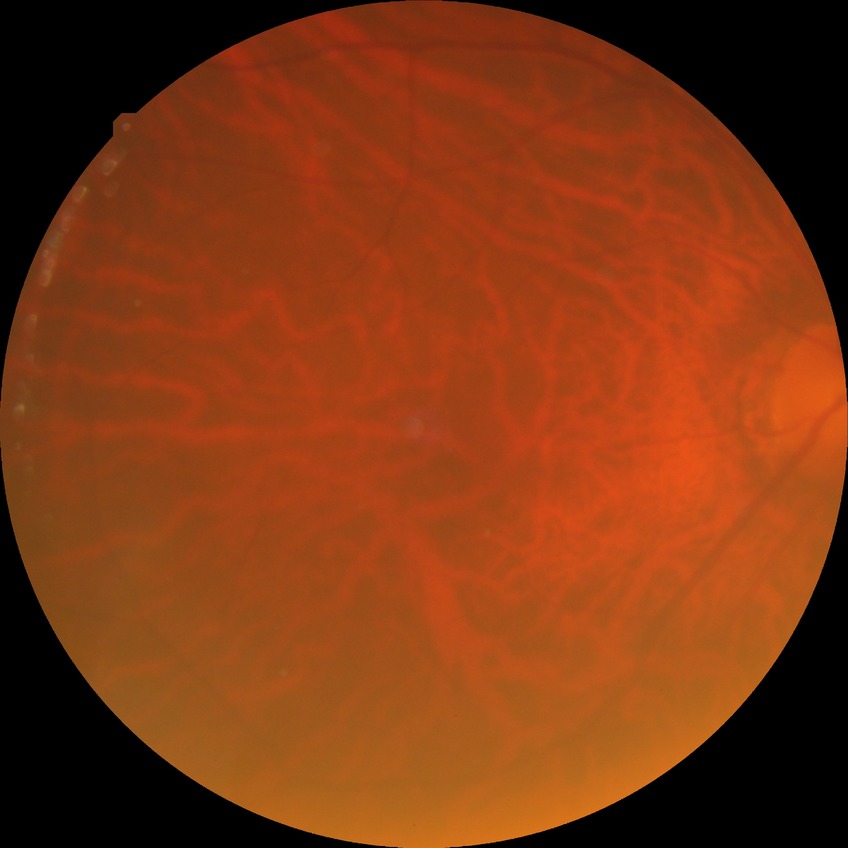
Diabetic retinopathy stage is no diabetic retinopathy.